Wide-field contact fundus photograph of an infant.
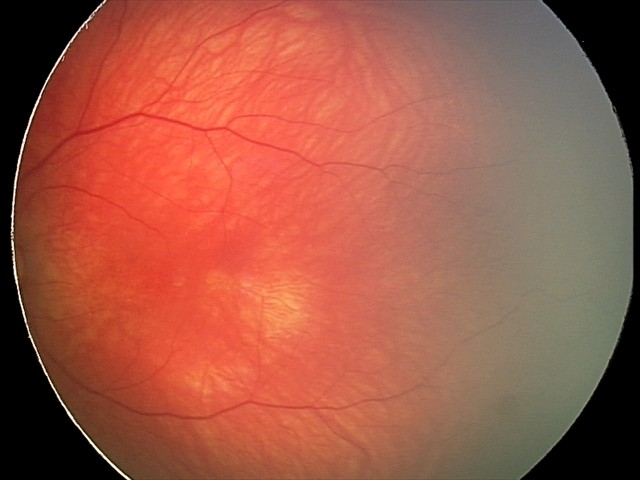
Impression: retinal hemorrhages.